Color fundus photograph
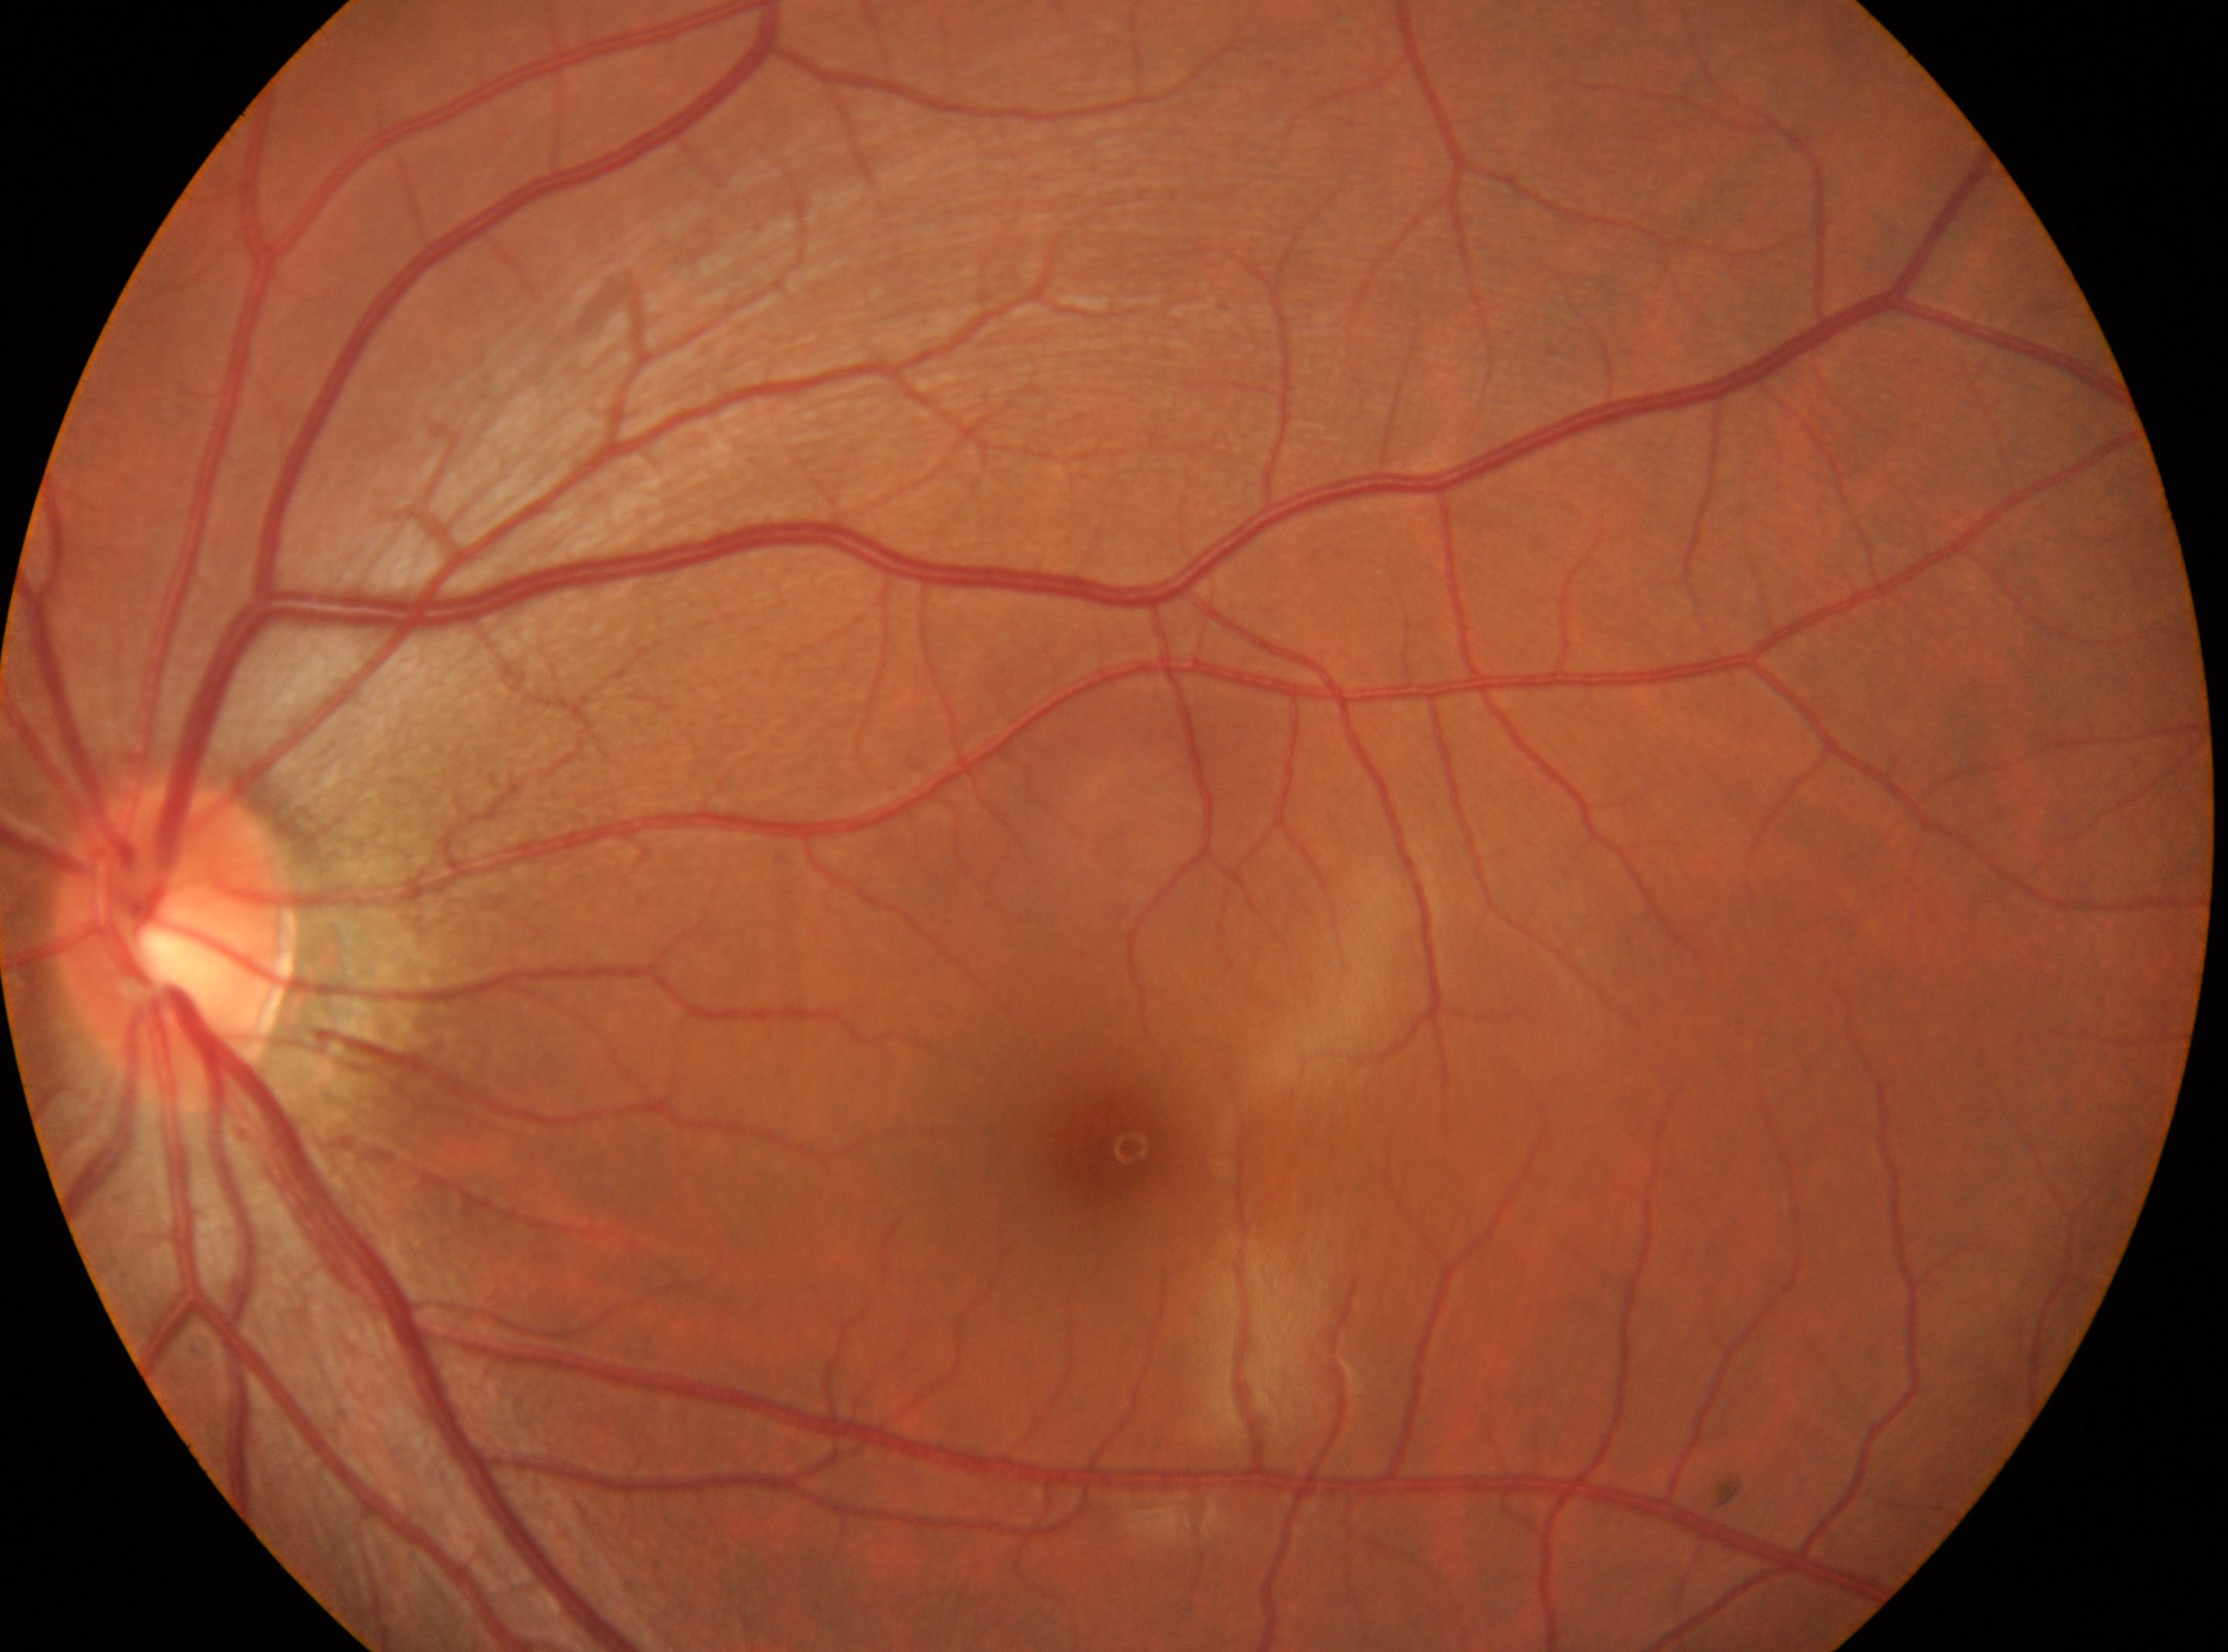
The fovea is at 1111px, 1143px.
No signs of diabetic retinopathy.
DR grade: 0/4.
Imaged eye: the left eye.
Optic disc located at 170px, 940px.